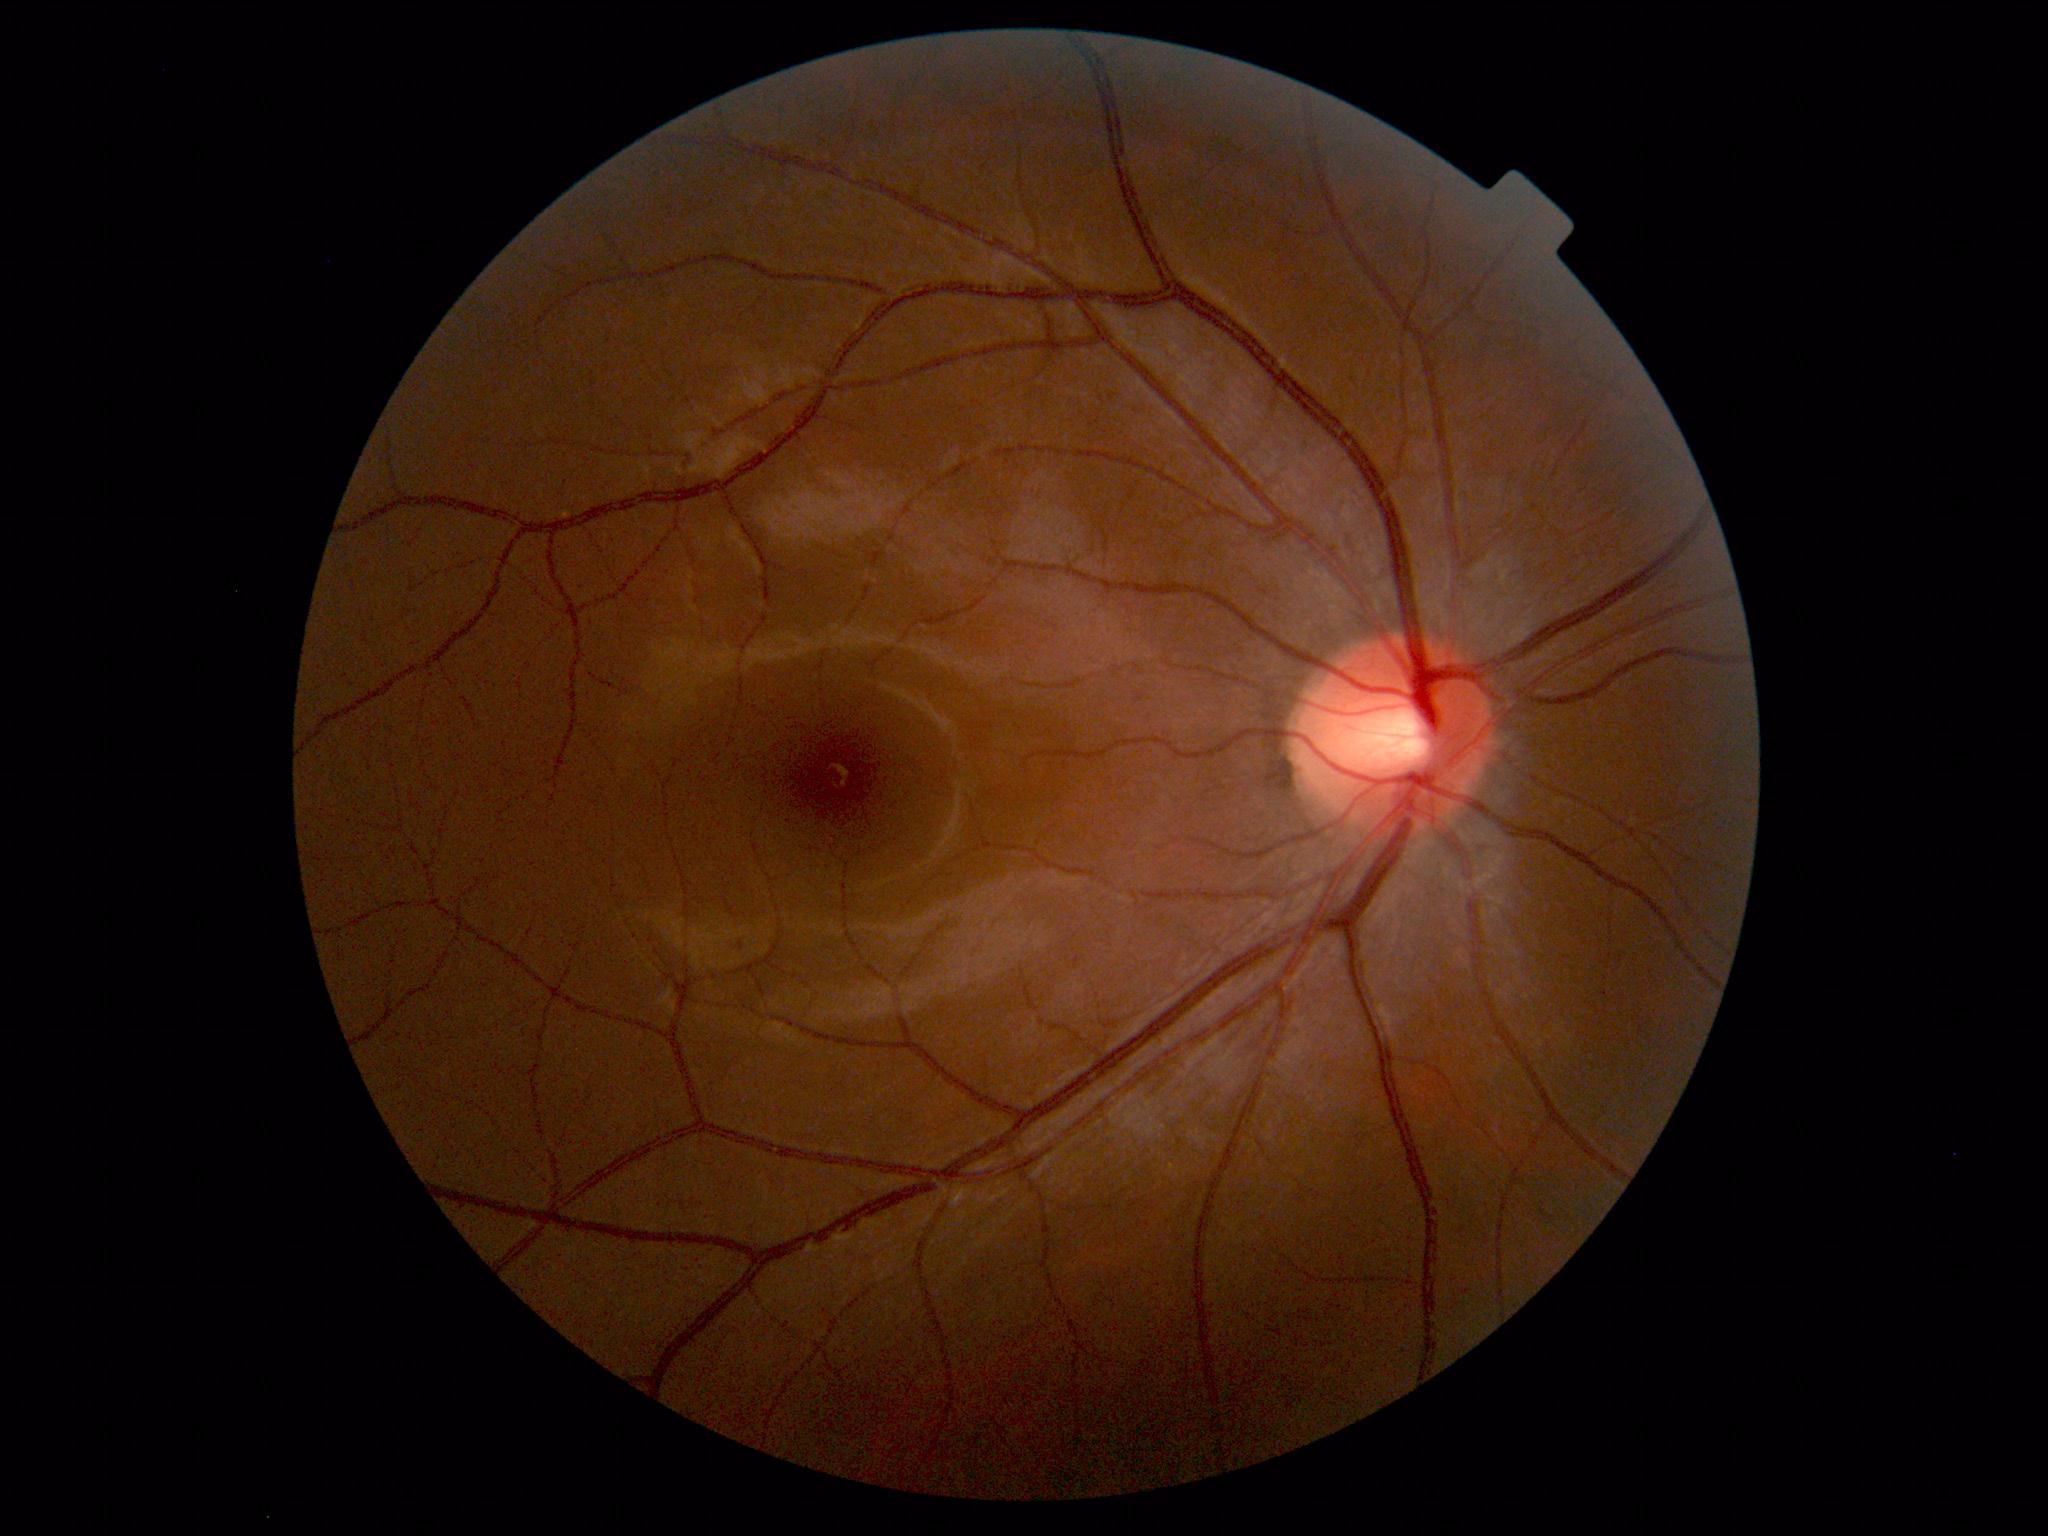

Impression: normal fundus.